DR severity per modified Davis staging
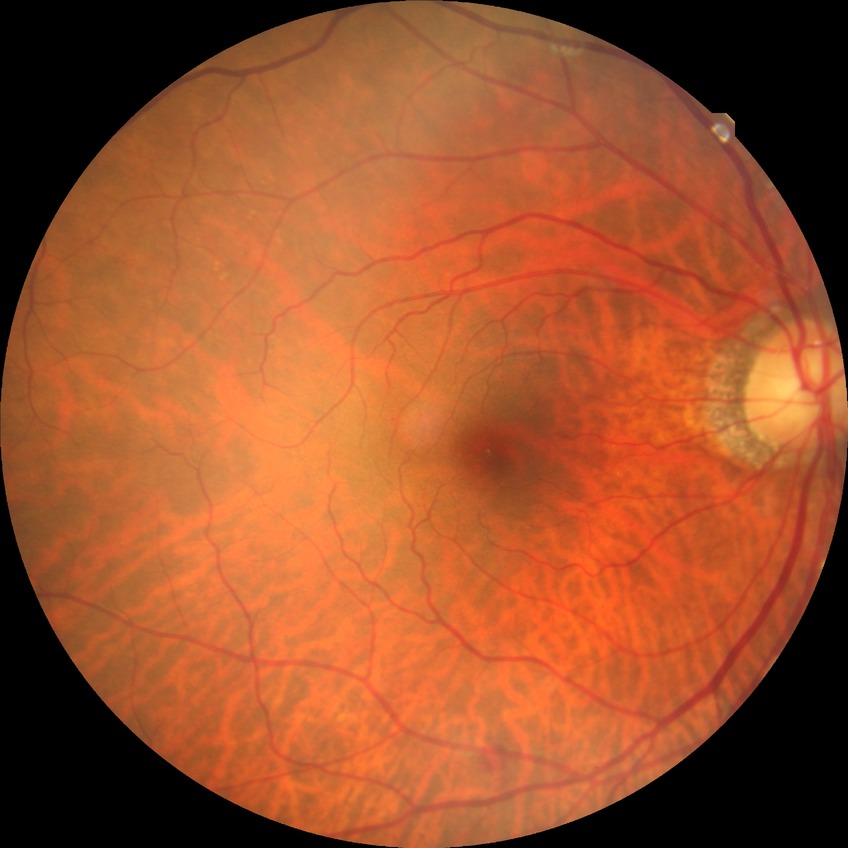

DR is SDR.